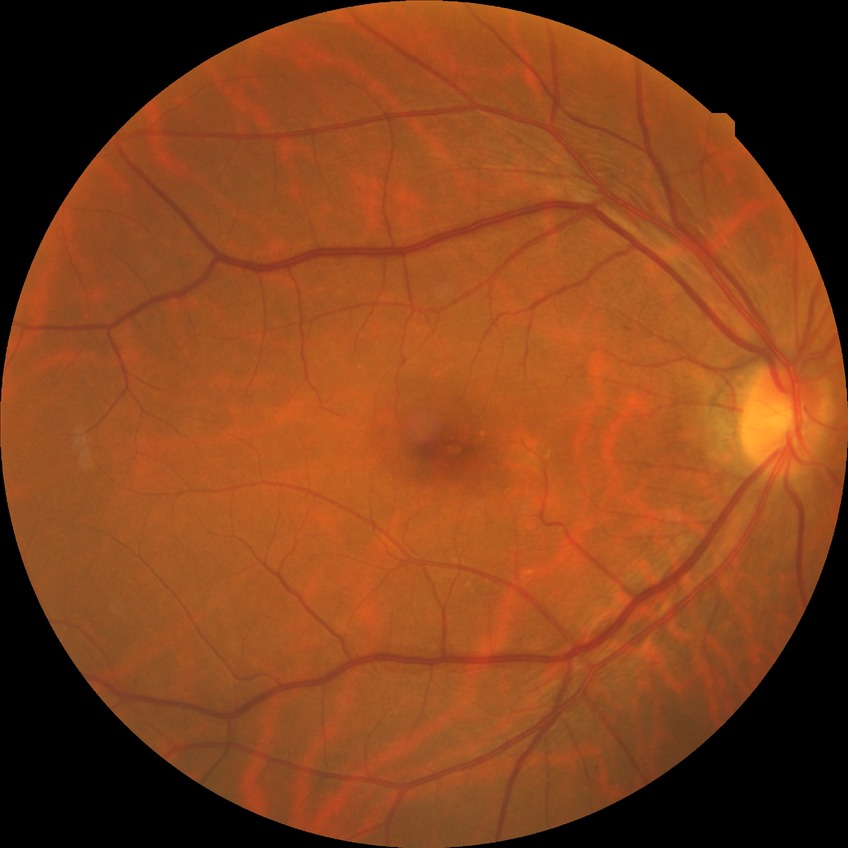 DR grade is NDR. No diabetic retinal disease findings.